2089x1764:
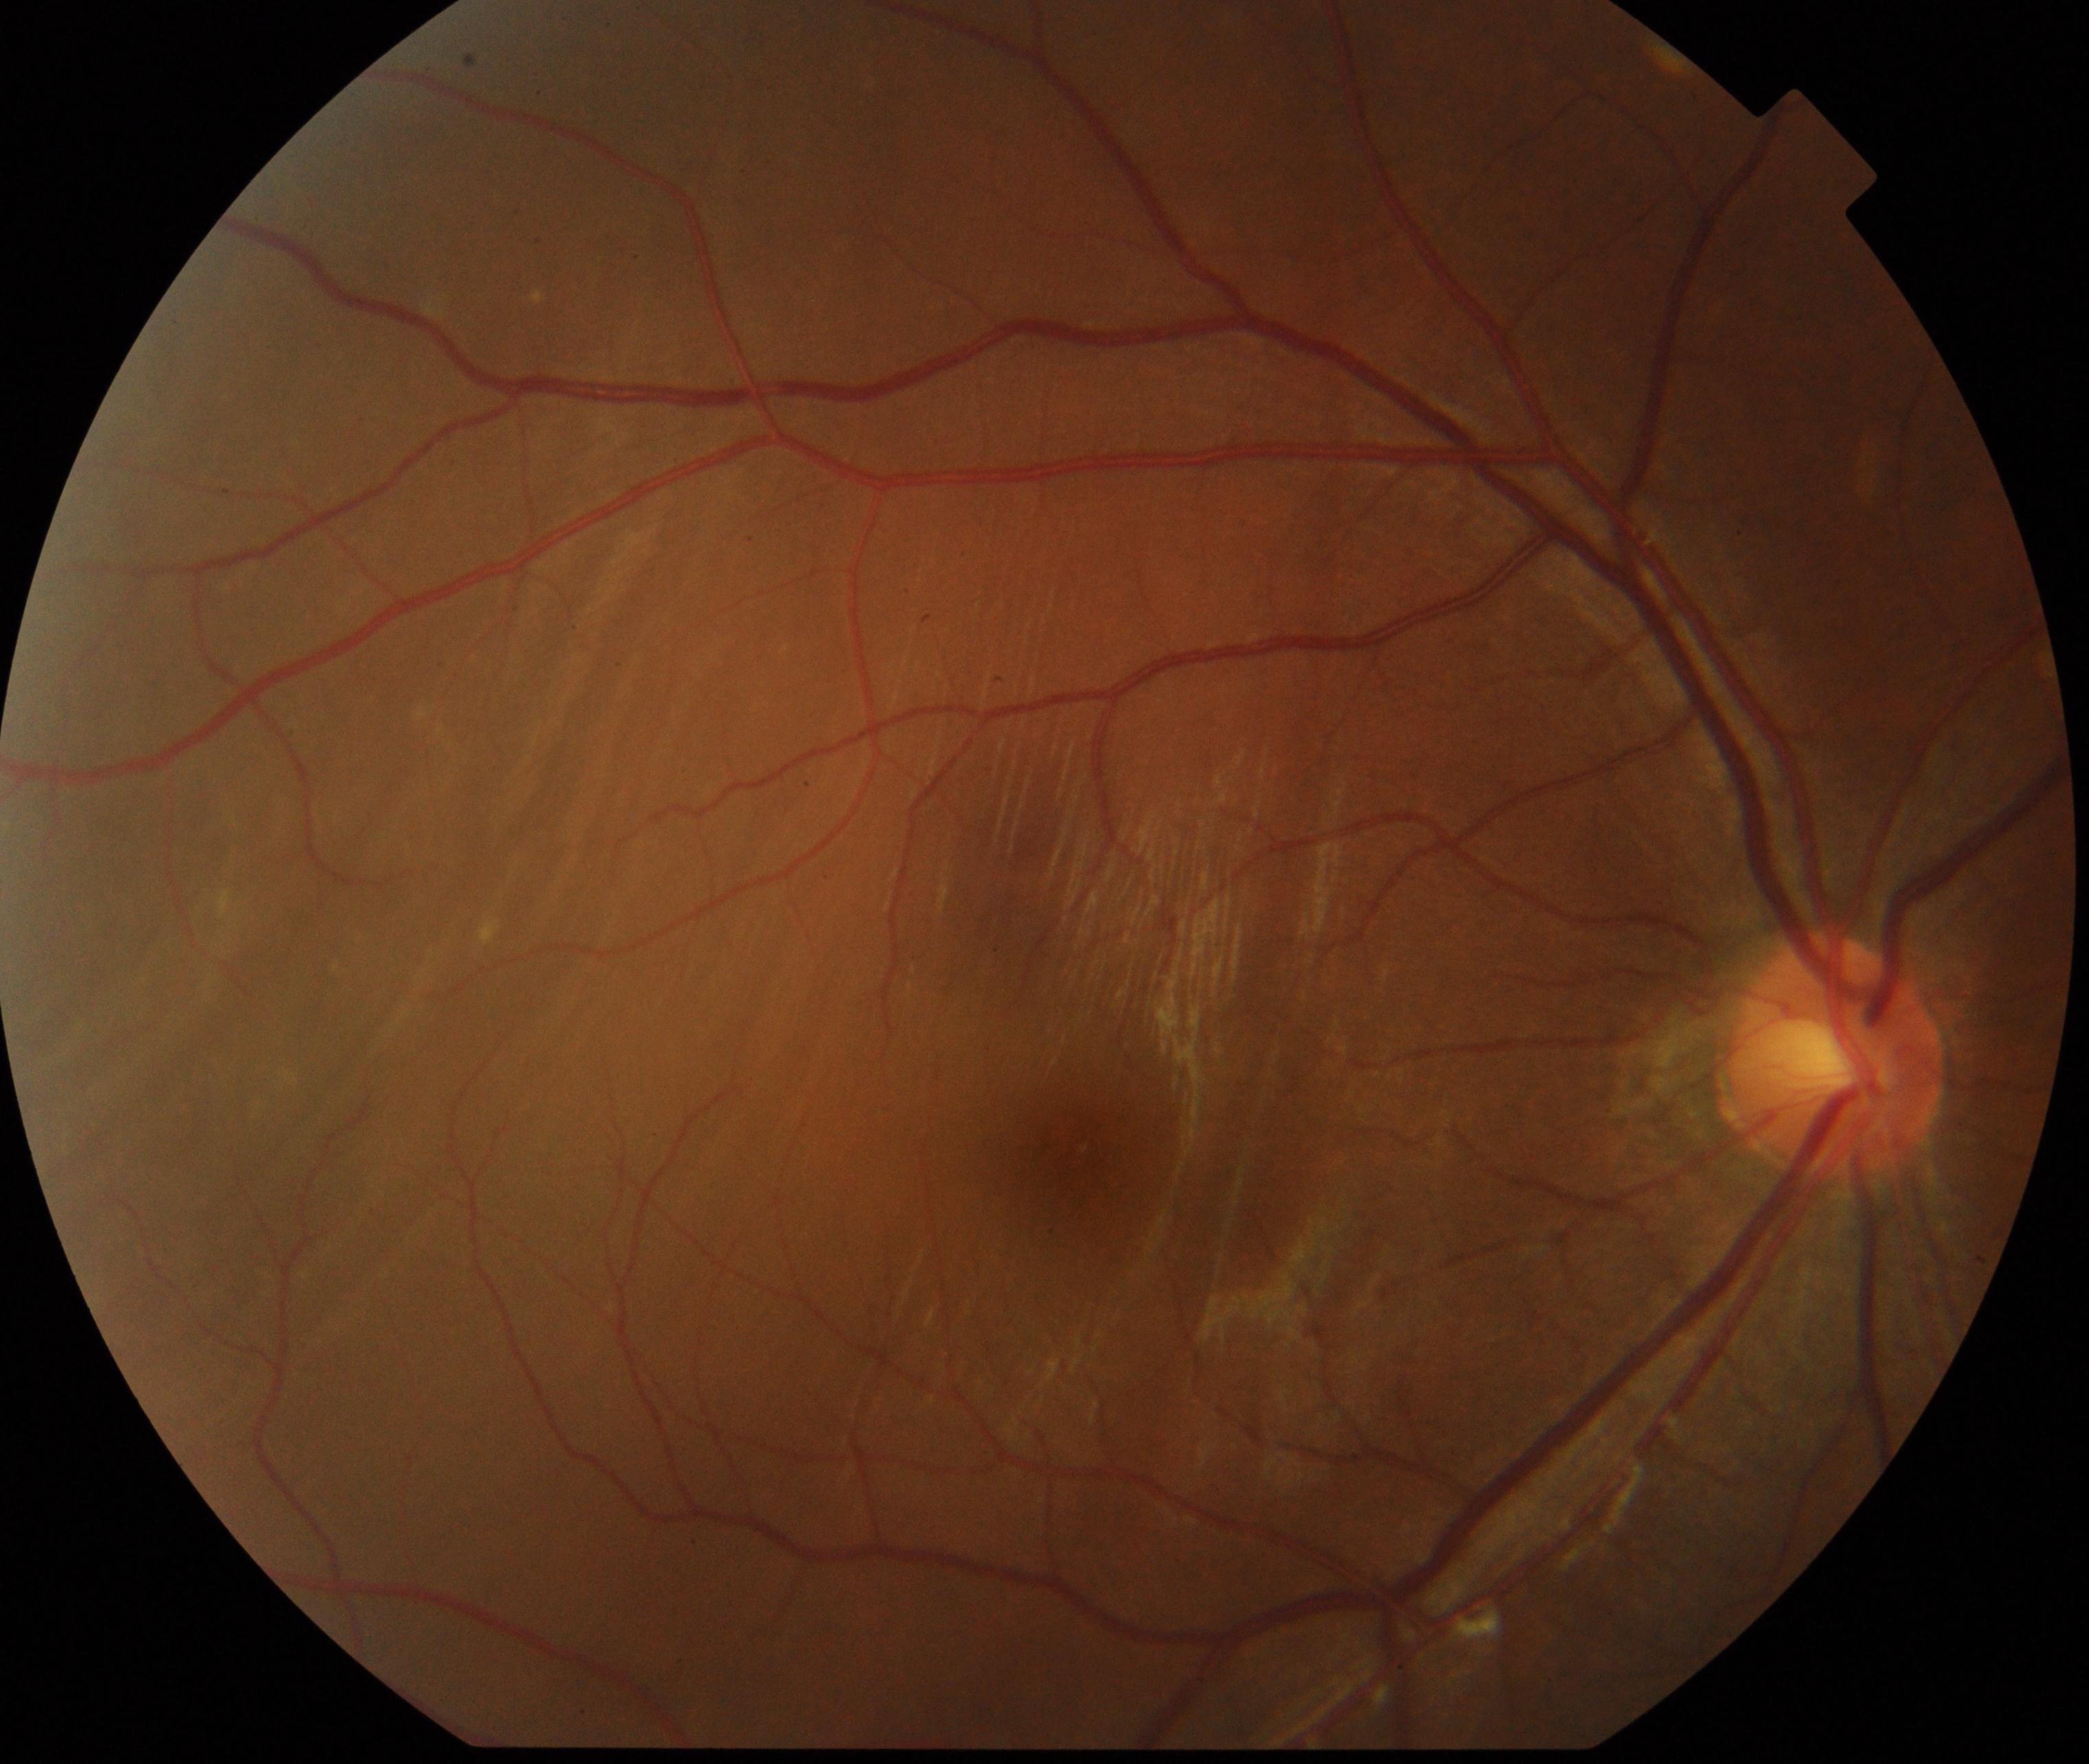
The image shows rhegmatogenous retinal detachment.